Posterior pole photograph; camera: NIDEK AFC-230; 45° field of view:
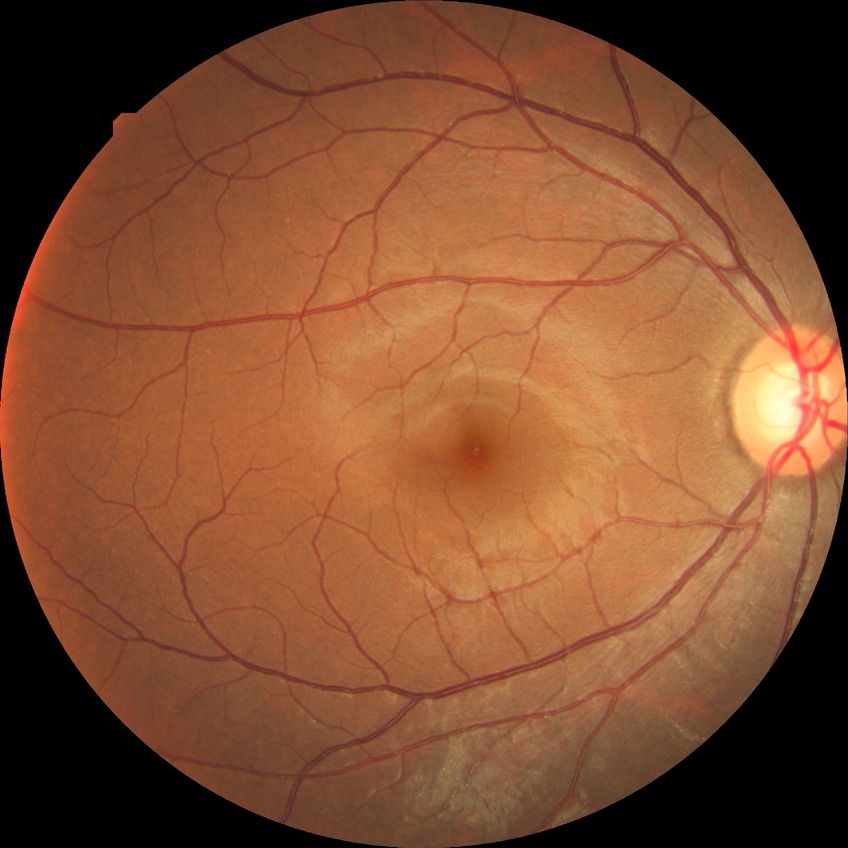
Modified Davis classification: no diabetic retinopathy.